45 degree fundus photograph, CFP.
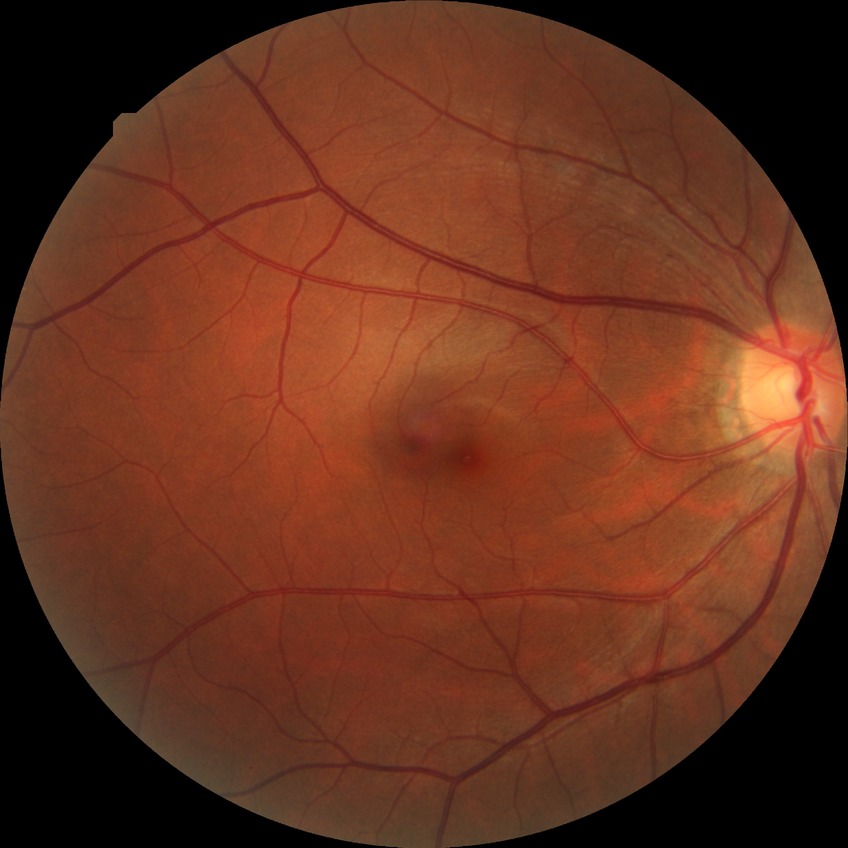
Retinopathy stage is no diabetic retinopathy.